Color fundus image; FOV: 45 degrees; 848 x 848 pixels; NIDEK AFC-230; no pharmacologic dilation — 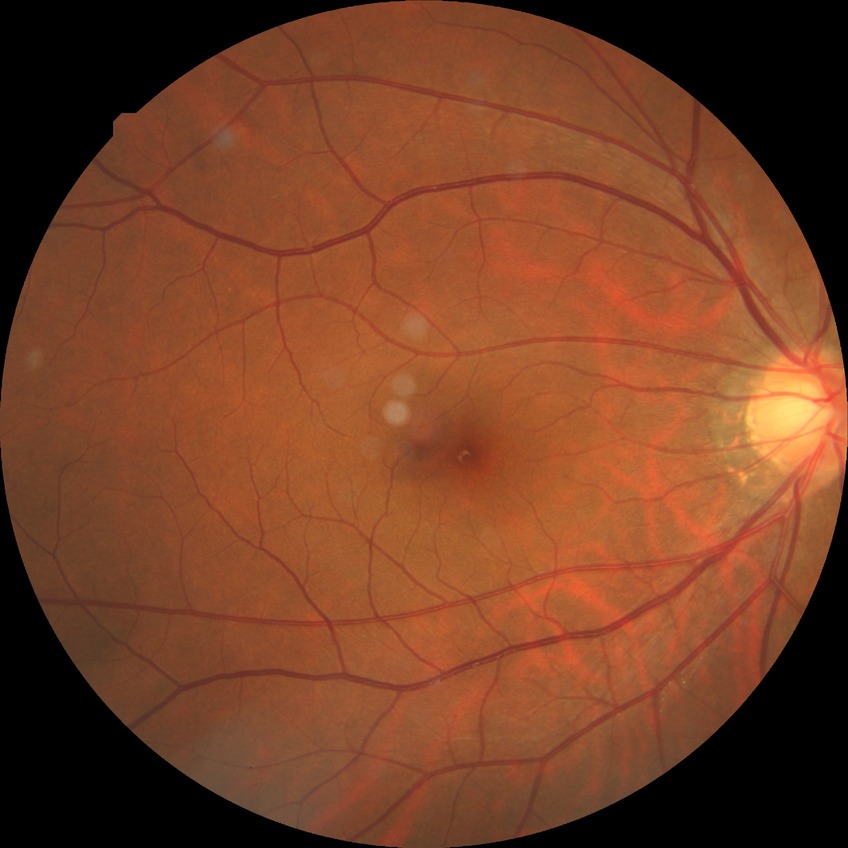
modified Davis grading: no diabetic retinopathy.